Macula at the center of the field. 50° field of view
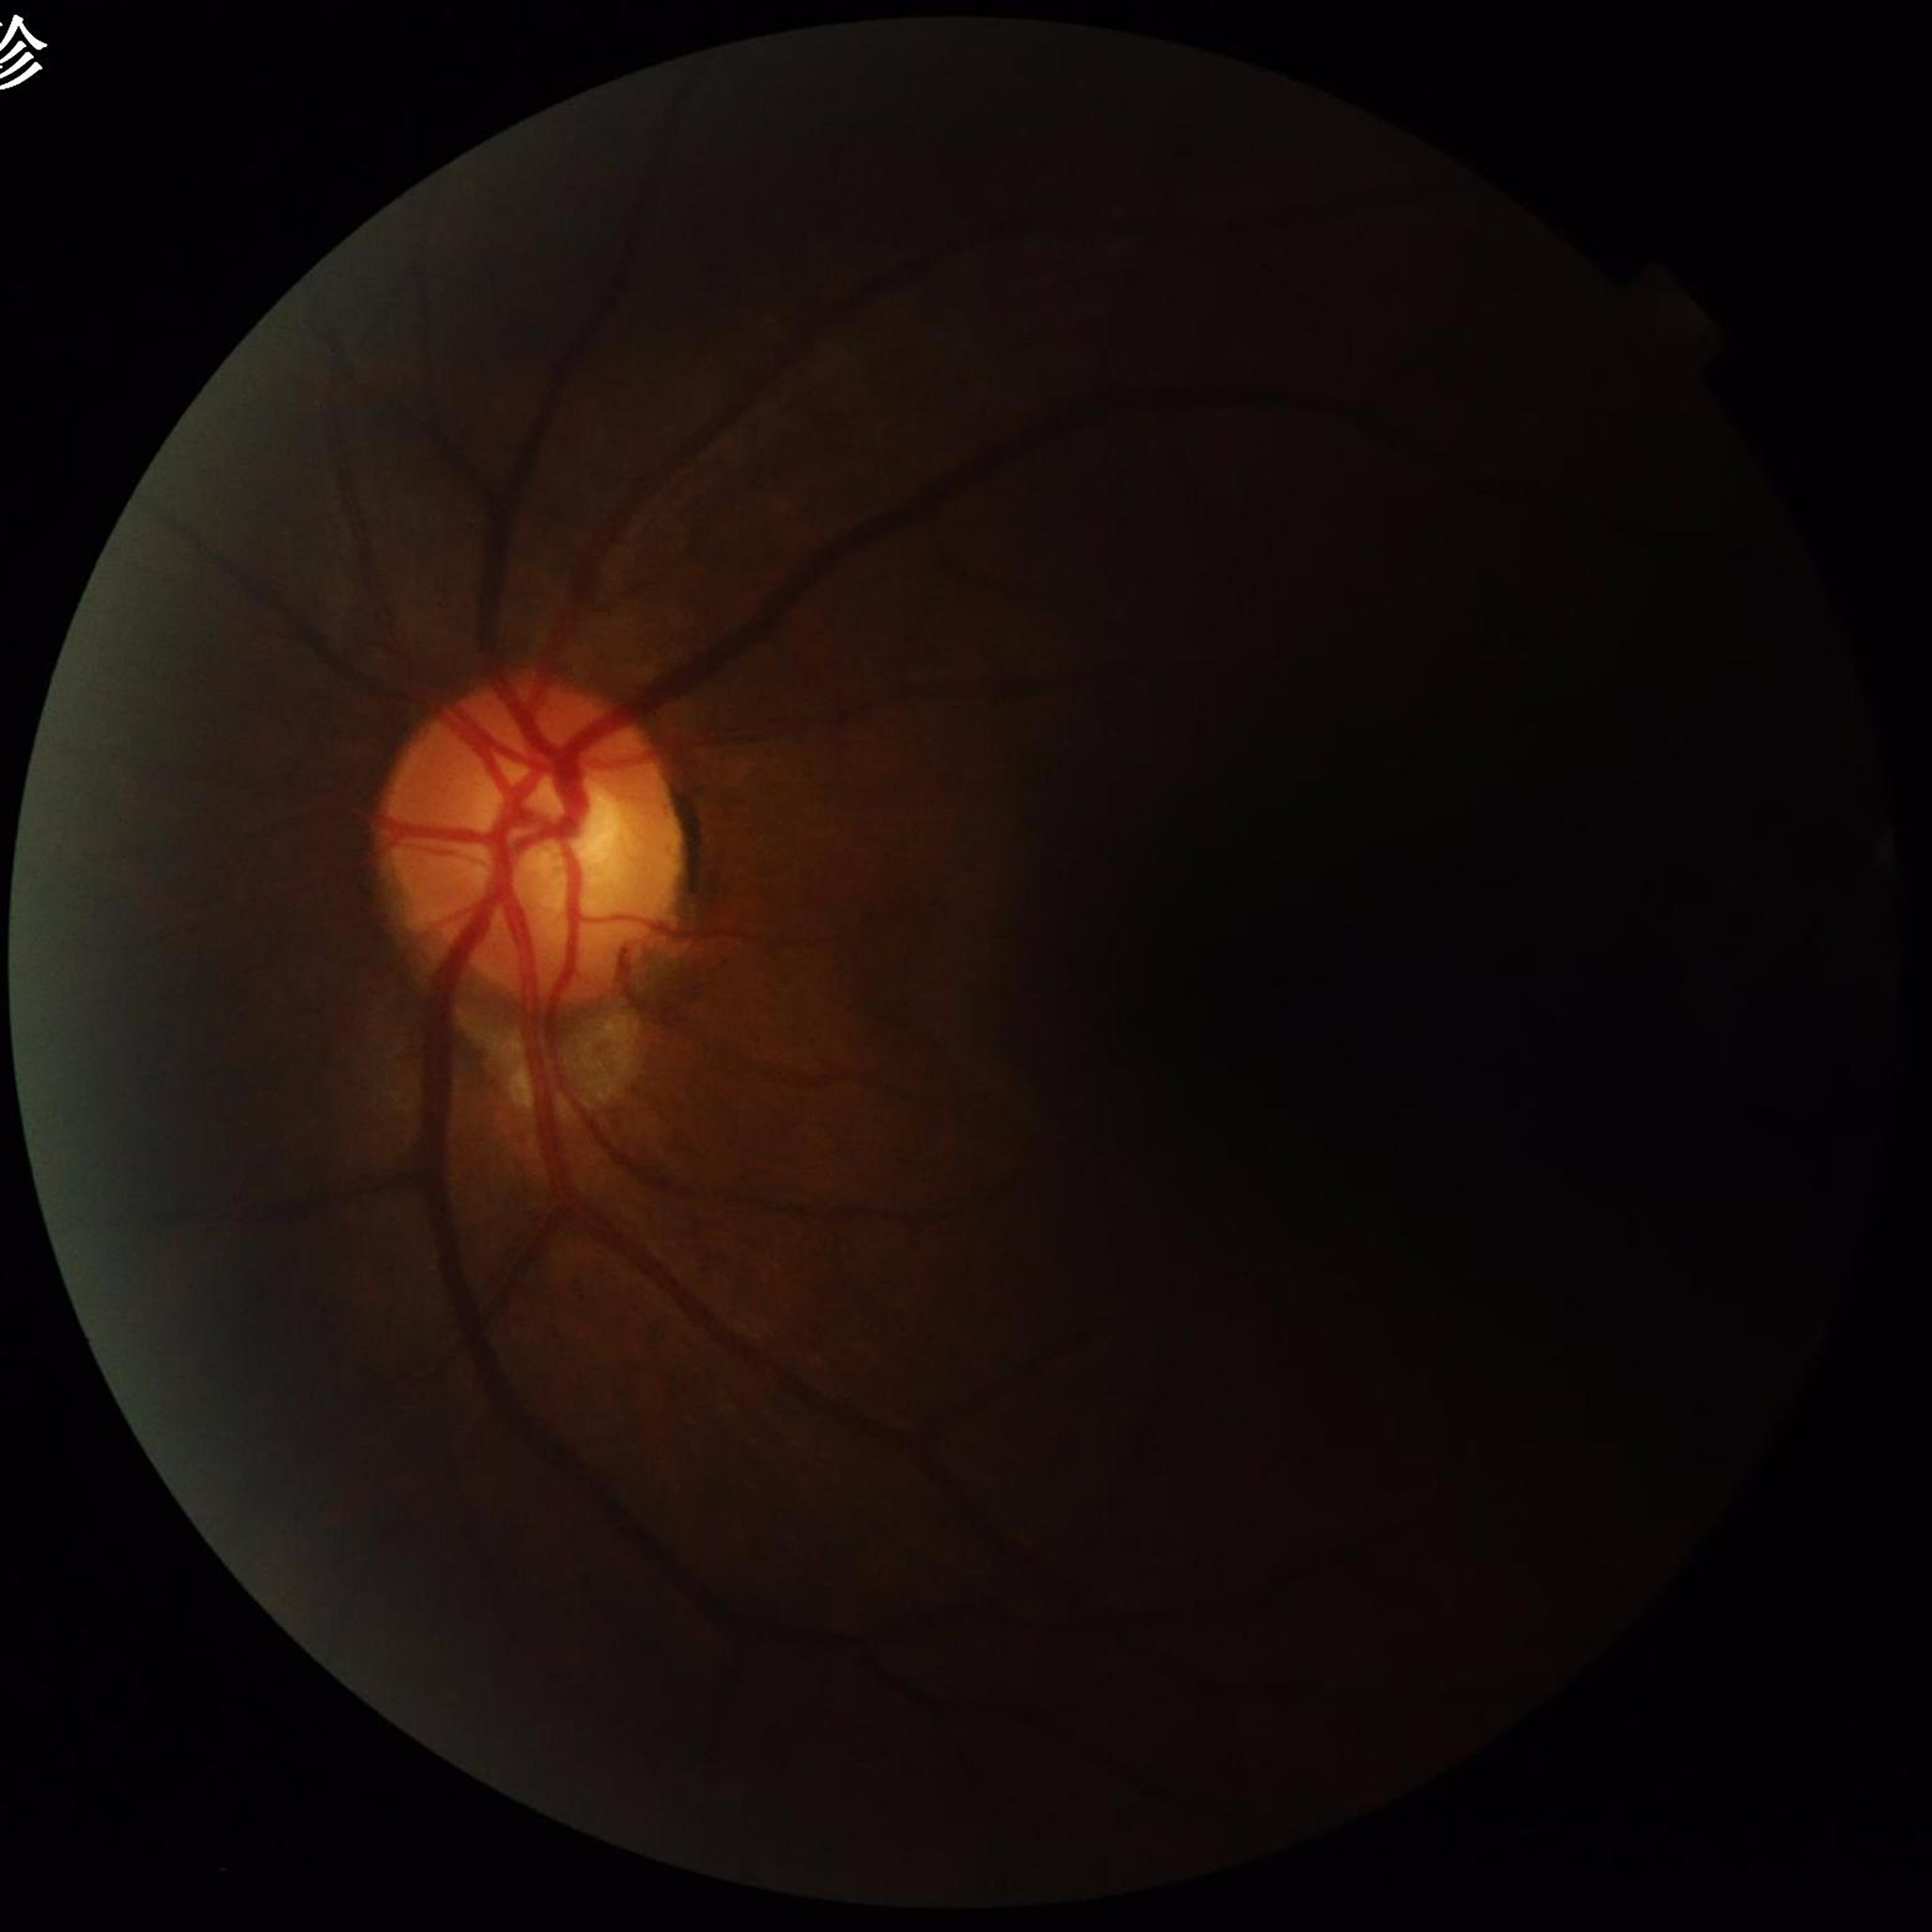
Photo quality = illumination/color distortion present, low contrast, no blur; Disease class = glaucoma.